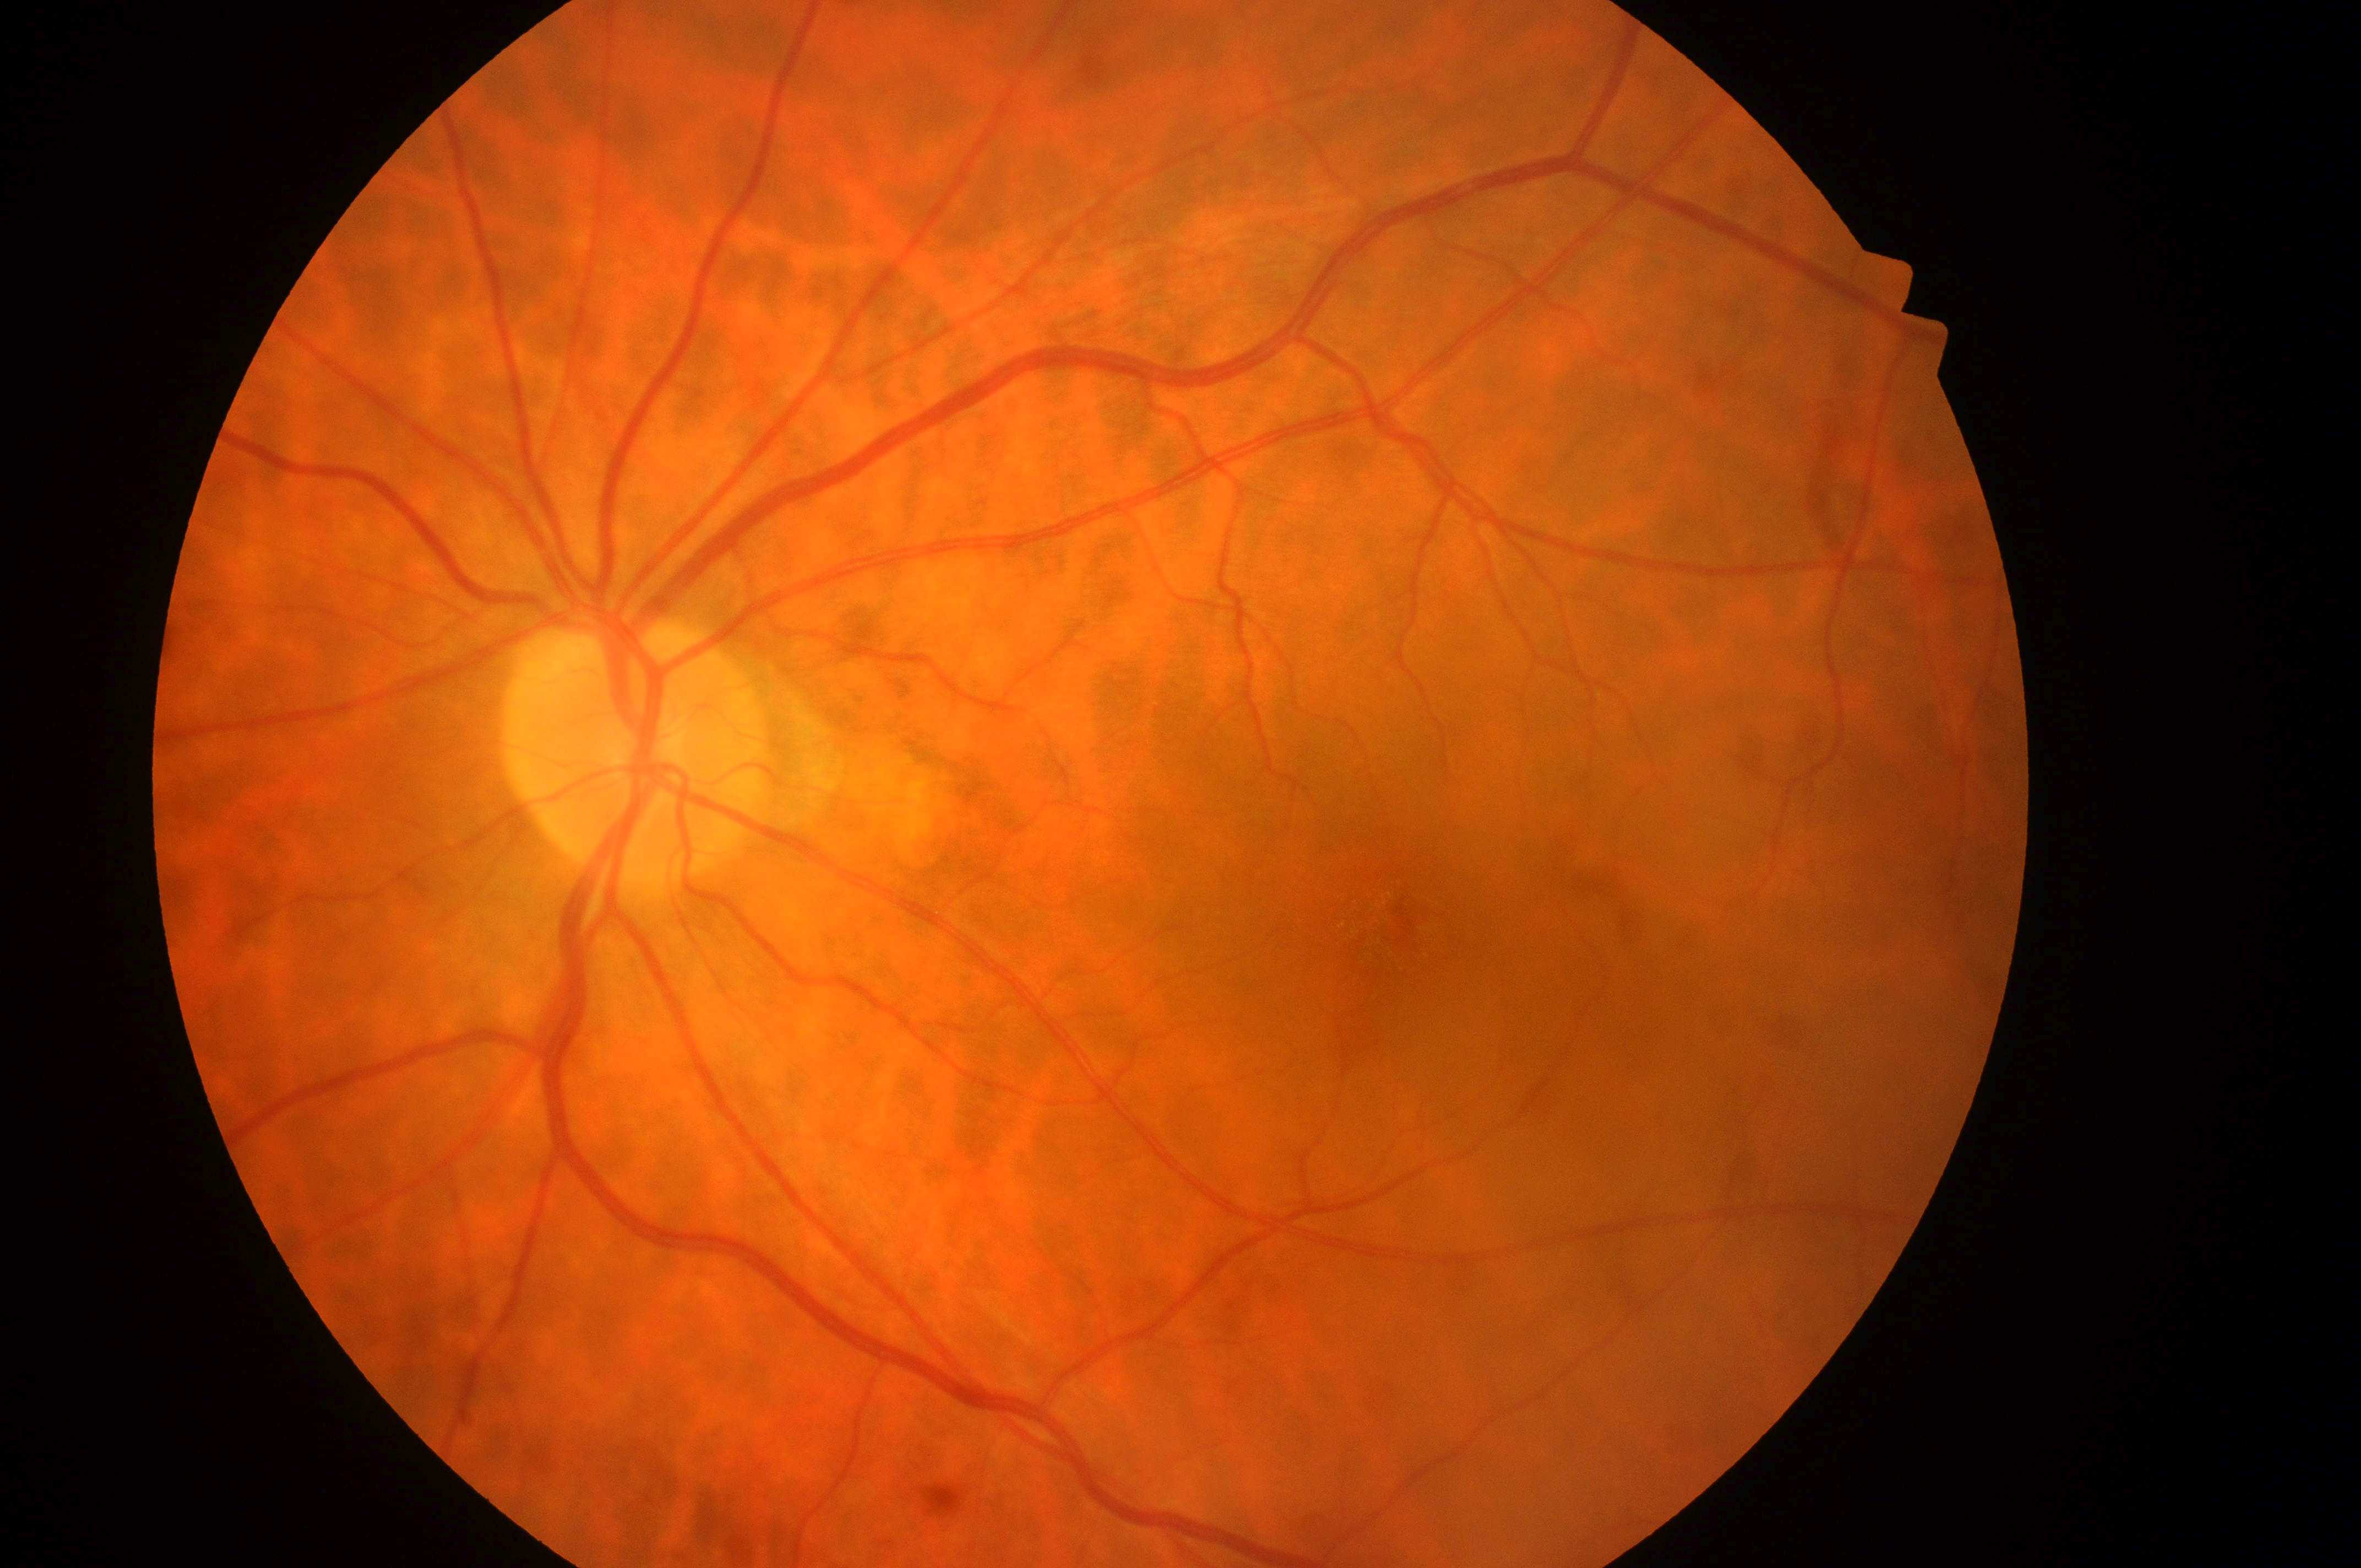 No diabetic retinal disease findings. Diabetic retinopathy grade is 0/4. Optic disc located at 637px, 756px. The image shows the oculus sinister. Fovea center: 1399px, 923px. Diabetic macular edema: 0/2.